1504x1000px — 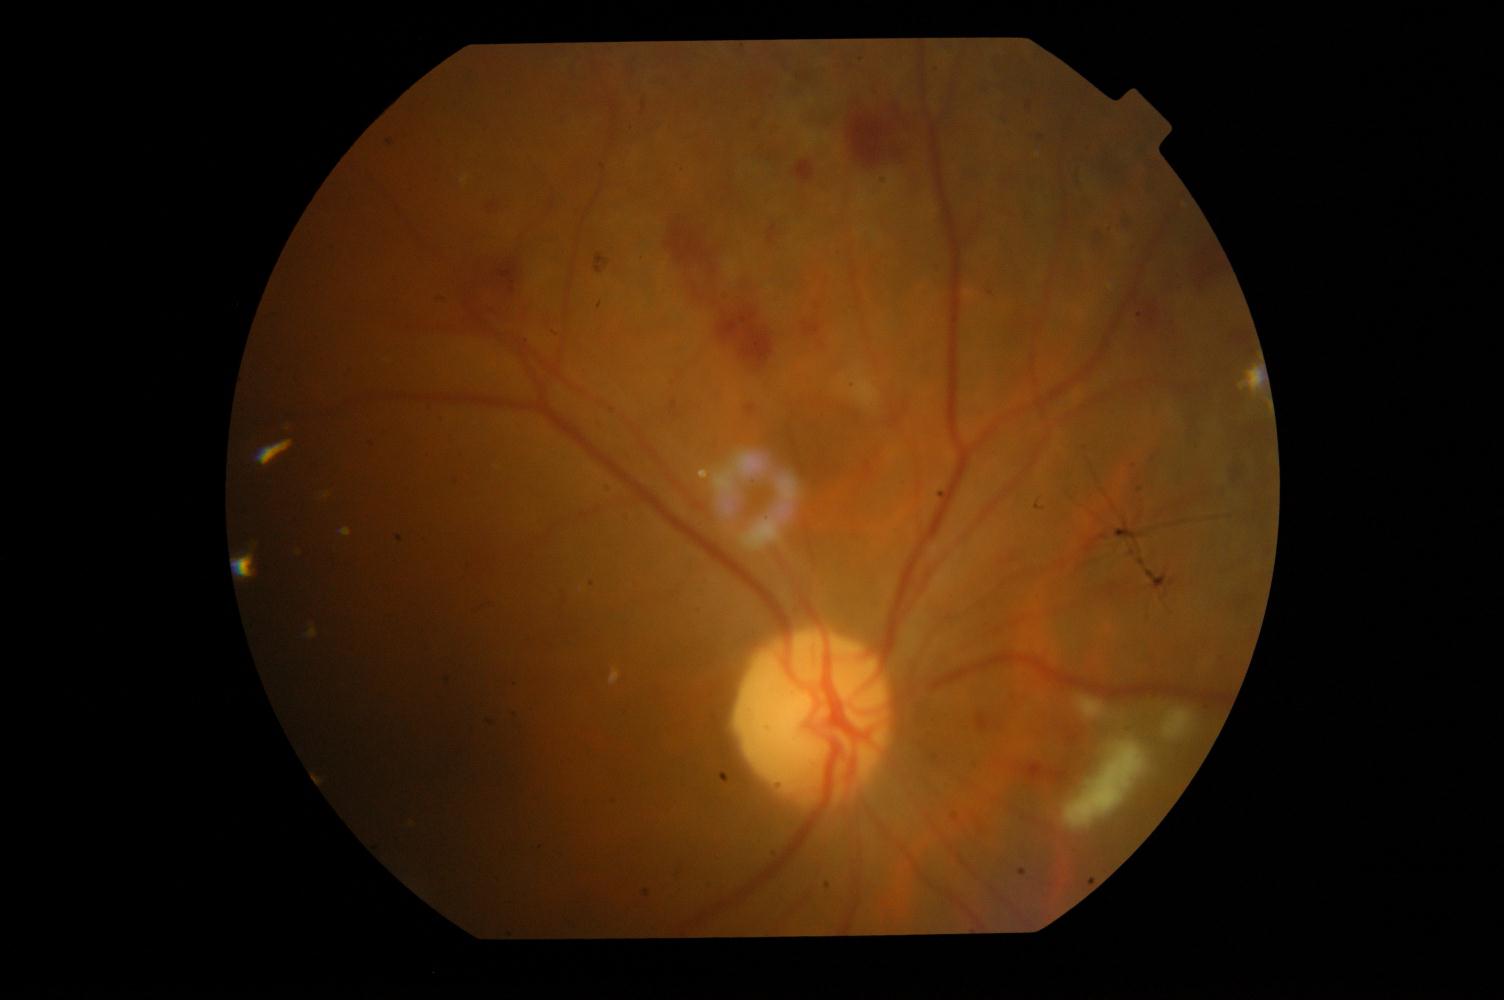 Abnormalities: DR (diabetic retinopathy).